45-degree field of view. 1380x1382 — 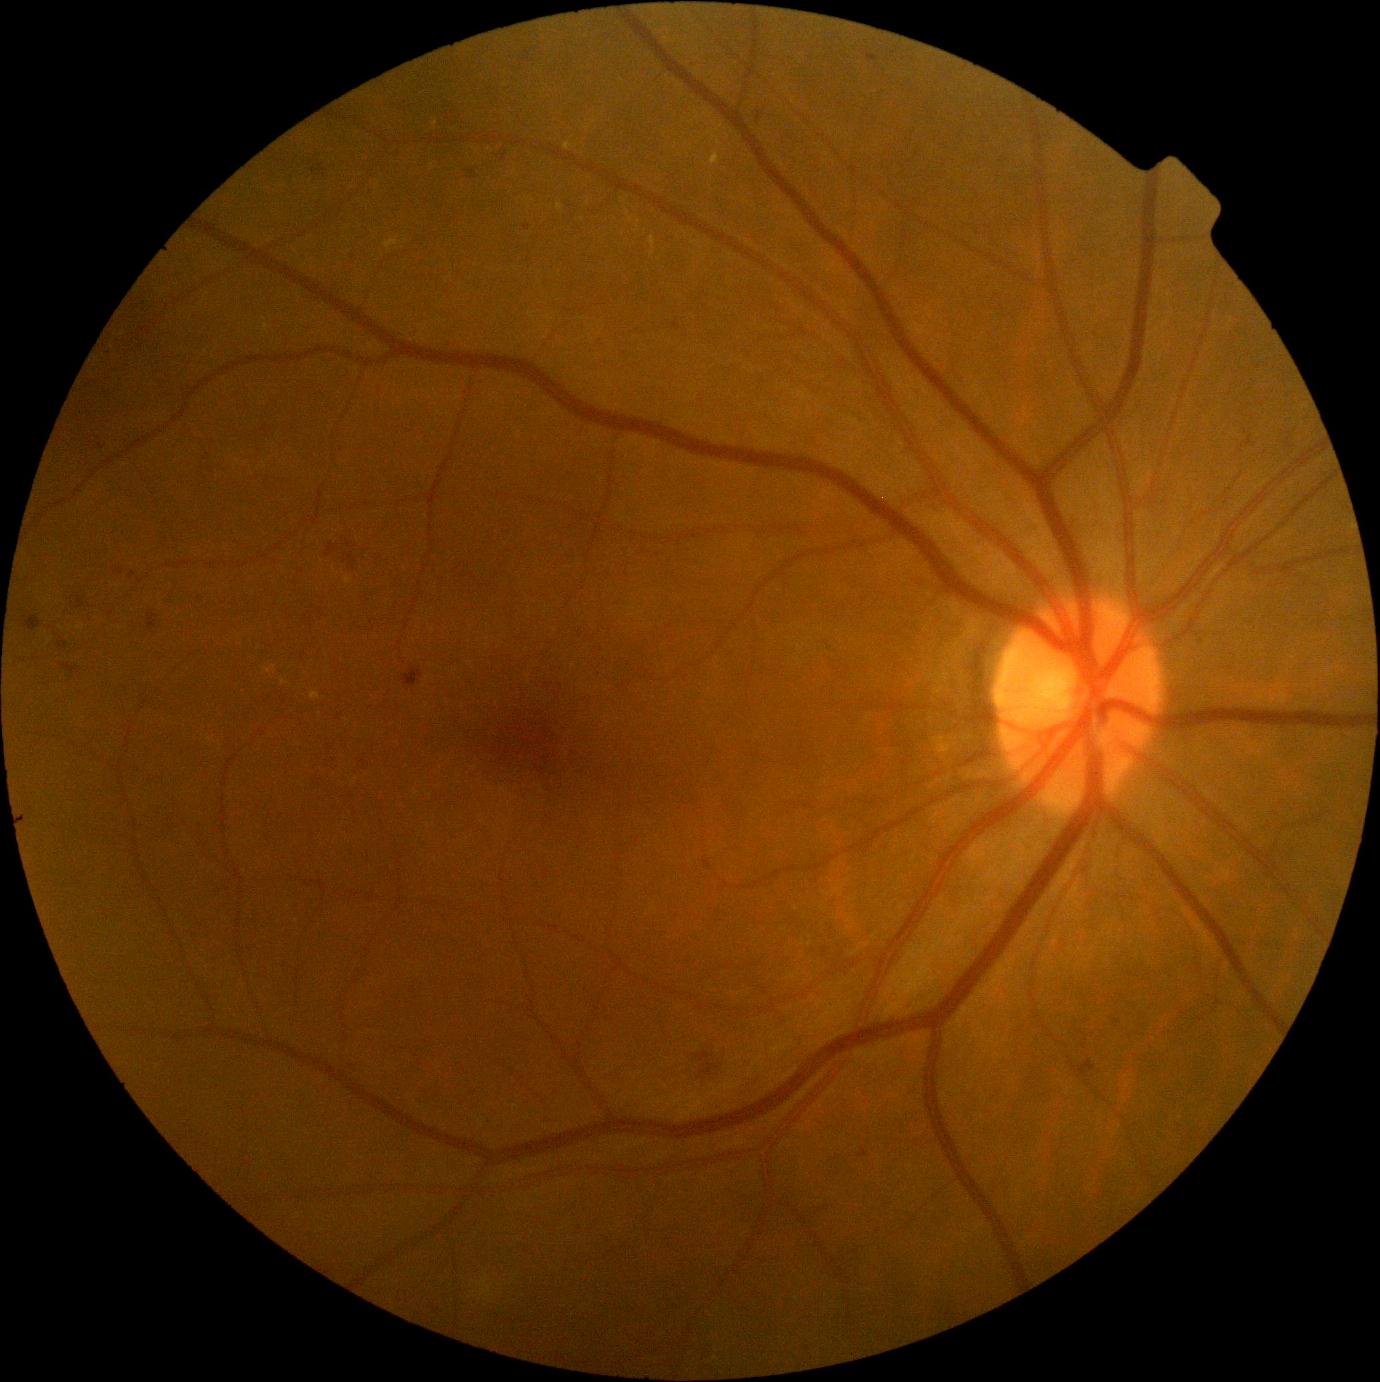

Retinopathy: 2/4.